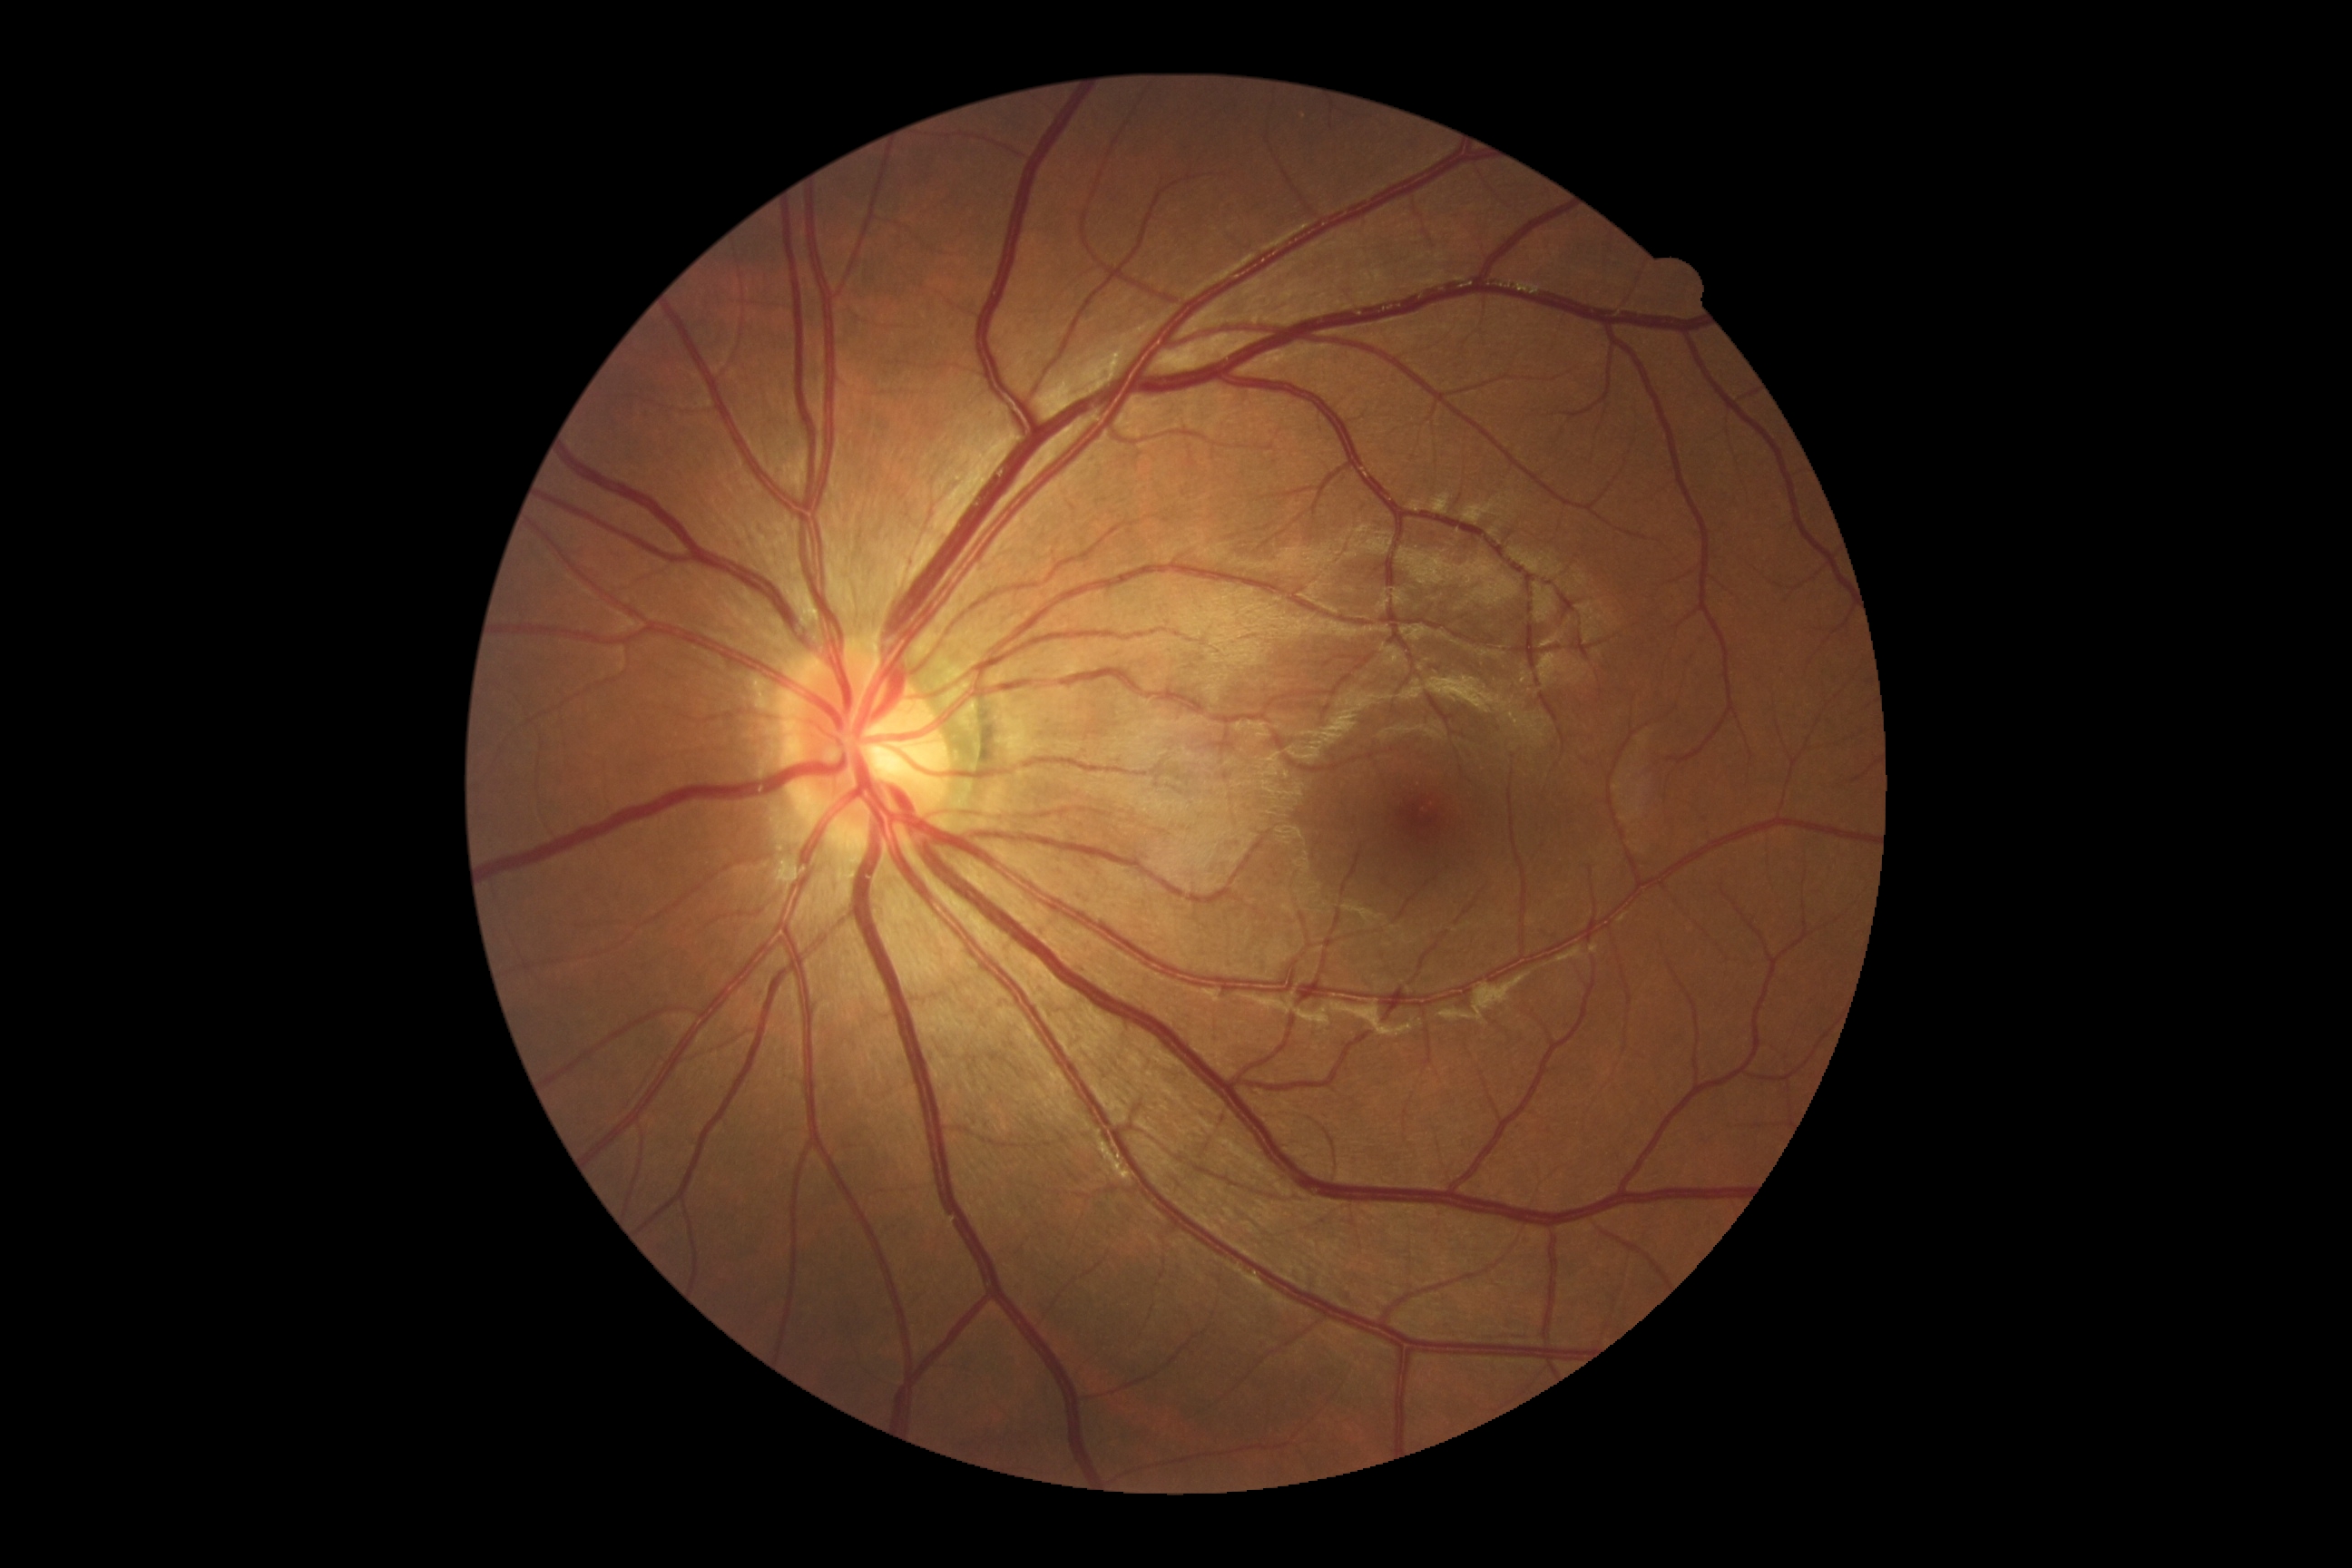 {
  "dr_impression": "no signs of DR",
  "dr_grade": "0"
}